Color fundus image.
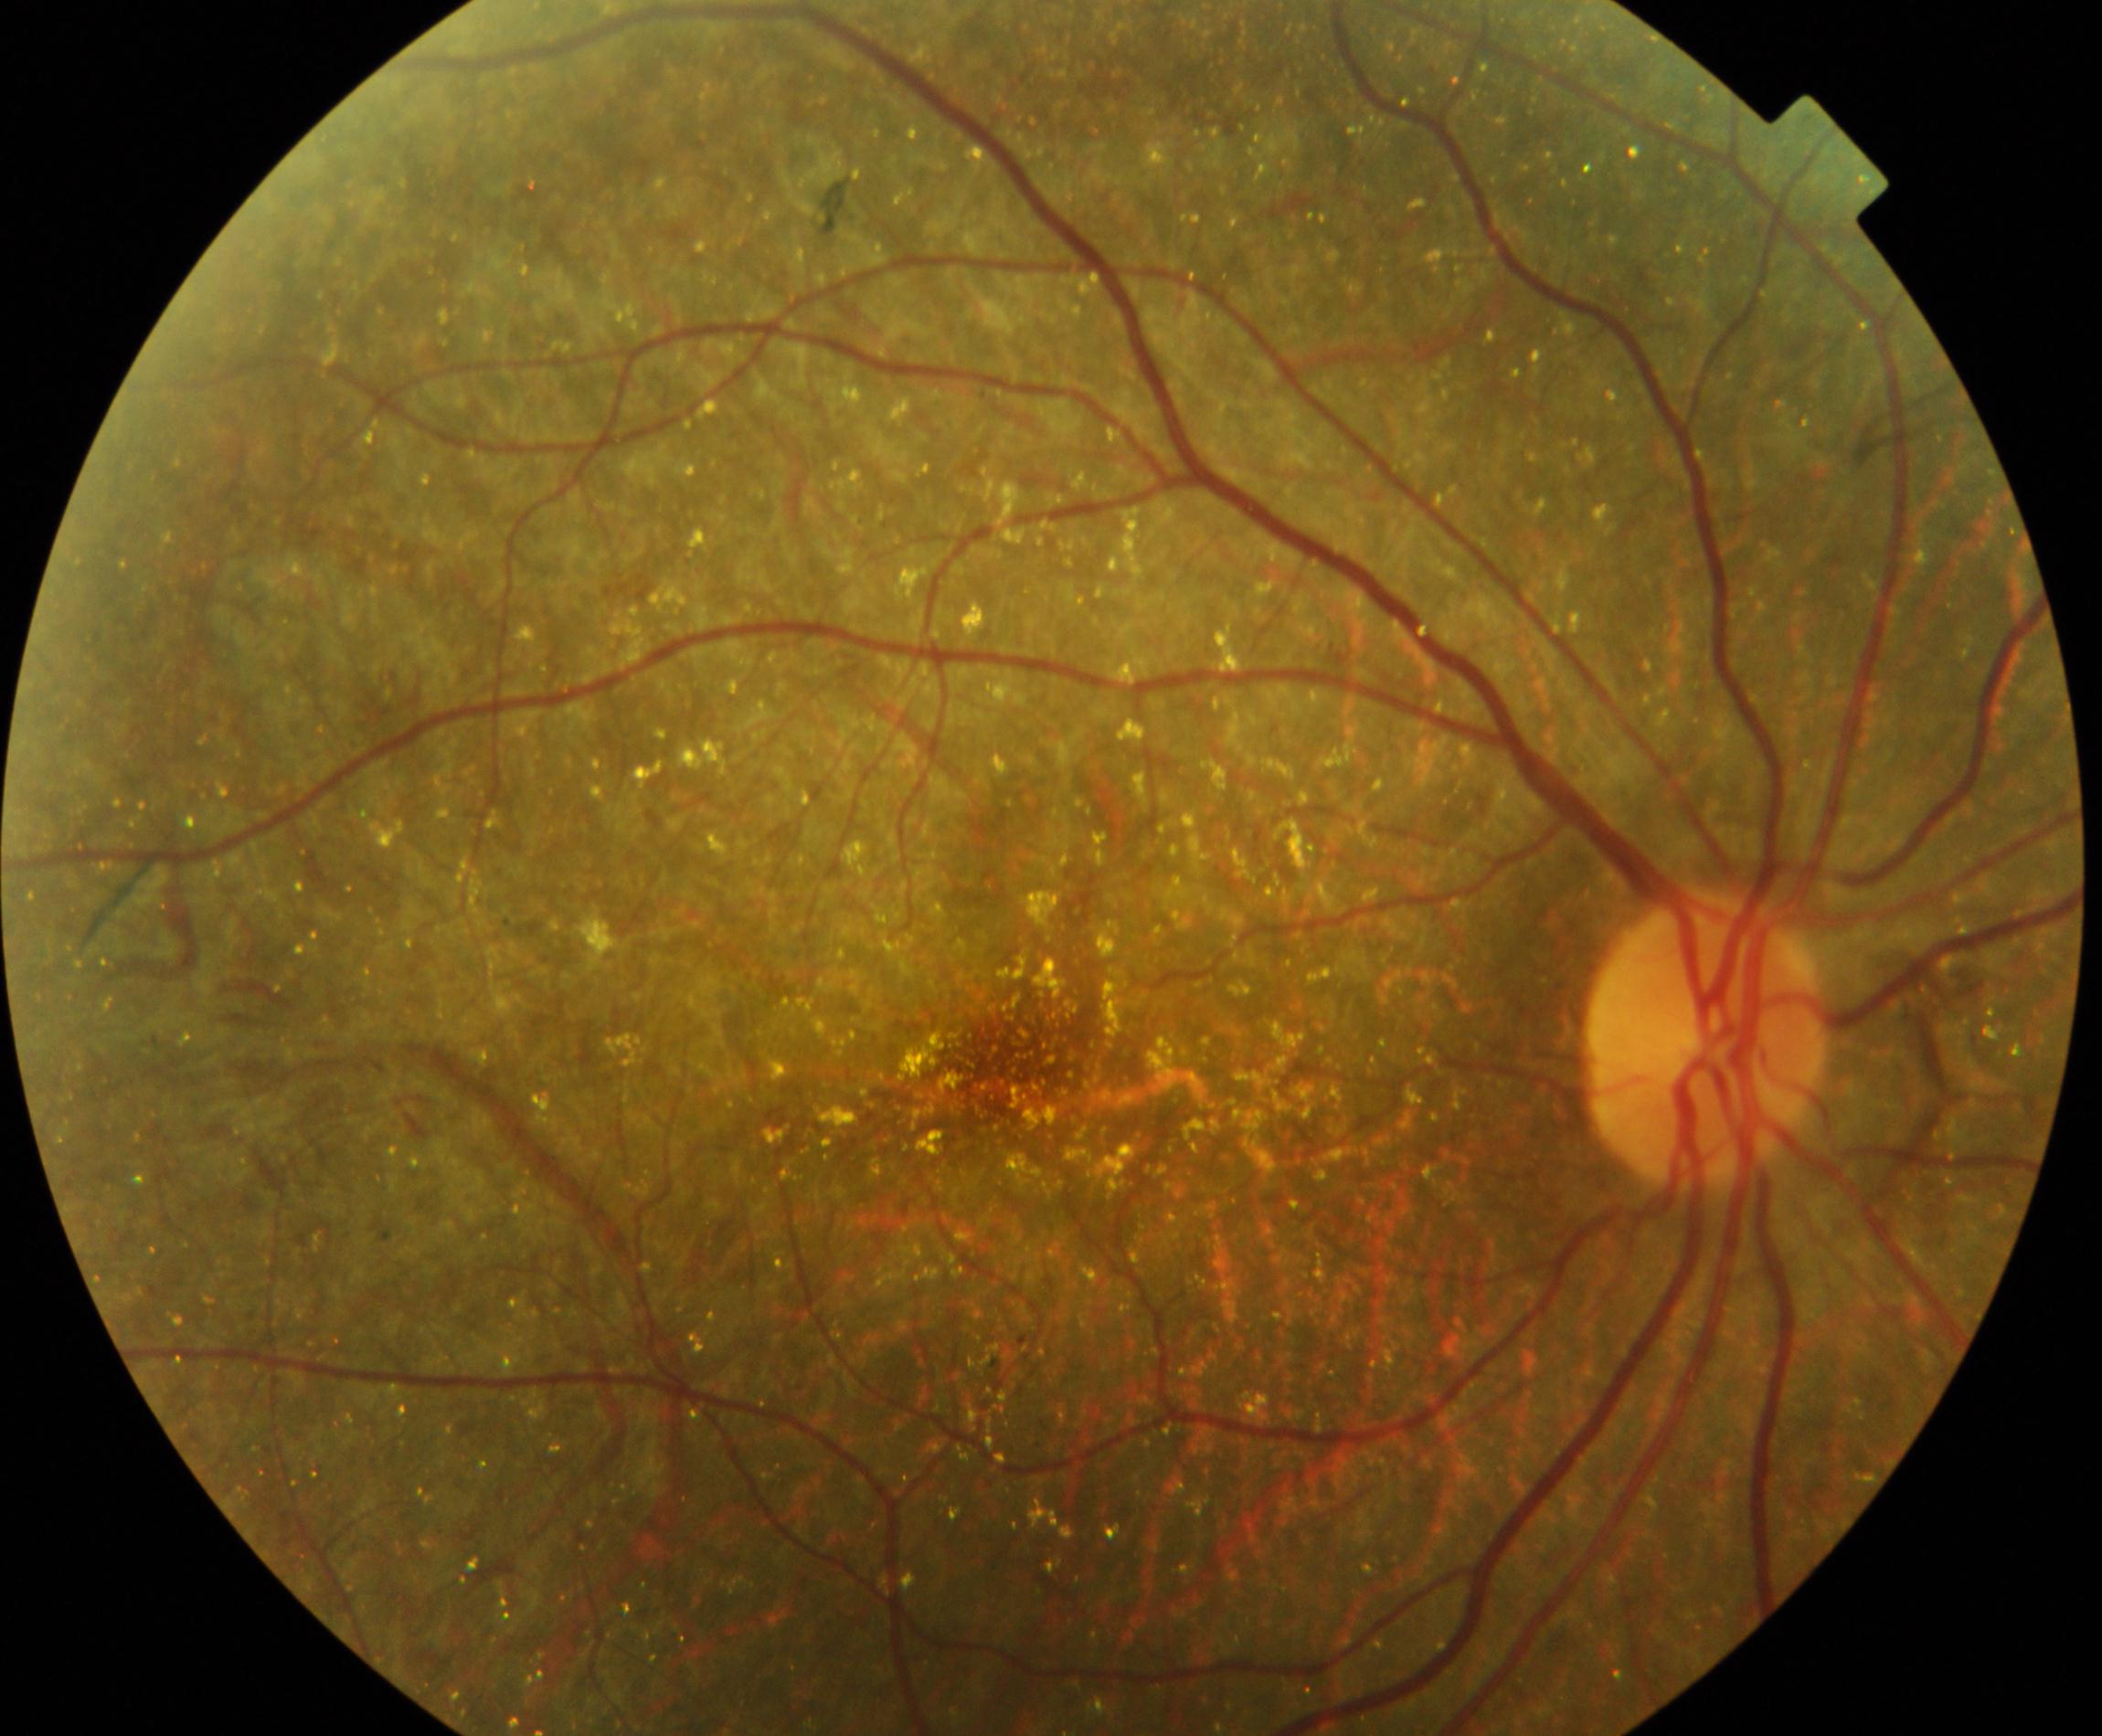
Findings: Bietti crystalline dystrophy.